Image size 640x480. Pediatric wide-field fundus photograph. Acquired on the Clarity RetCam 3:
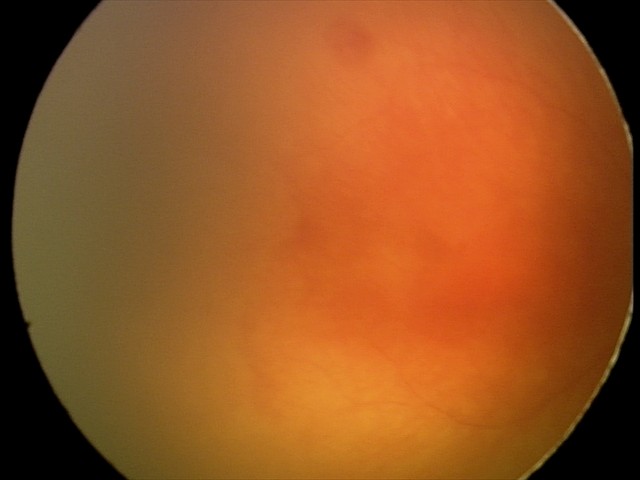

Impression: plus disease; aggressive ROP (A-ROP).